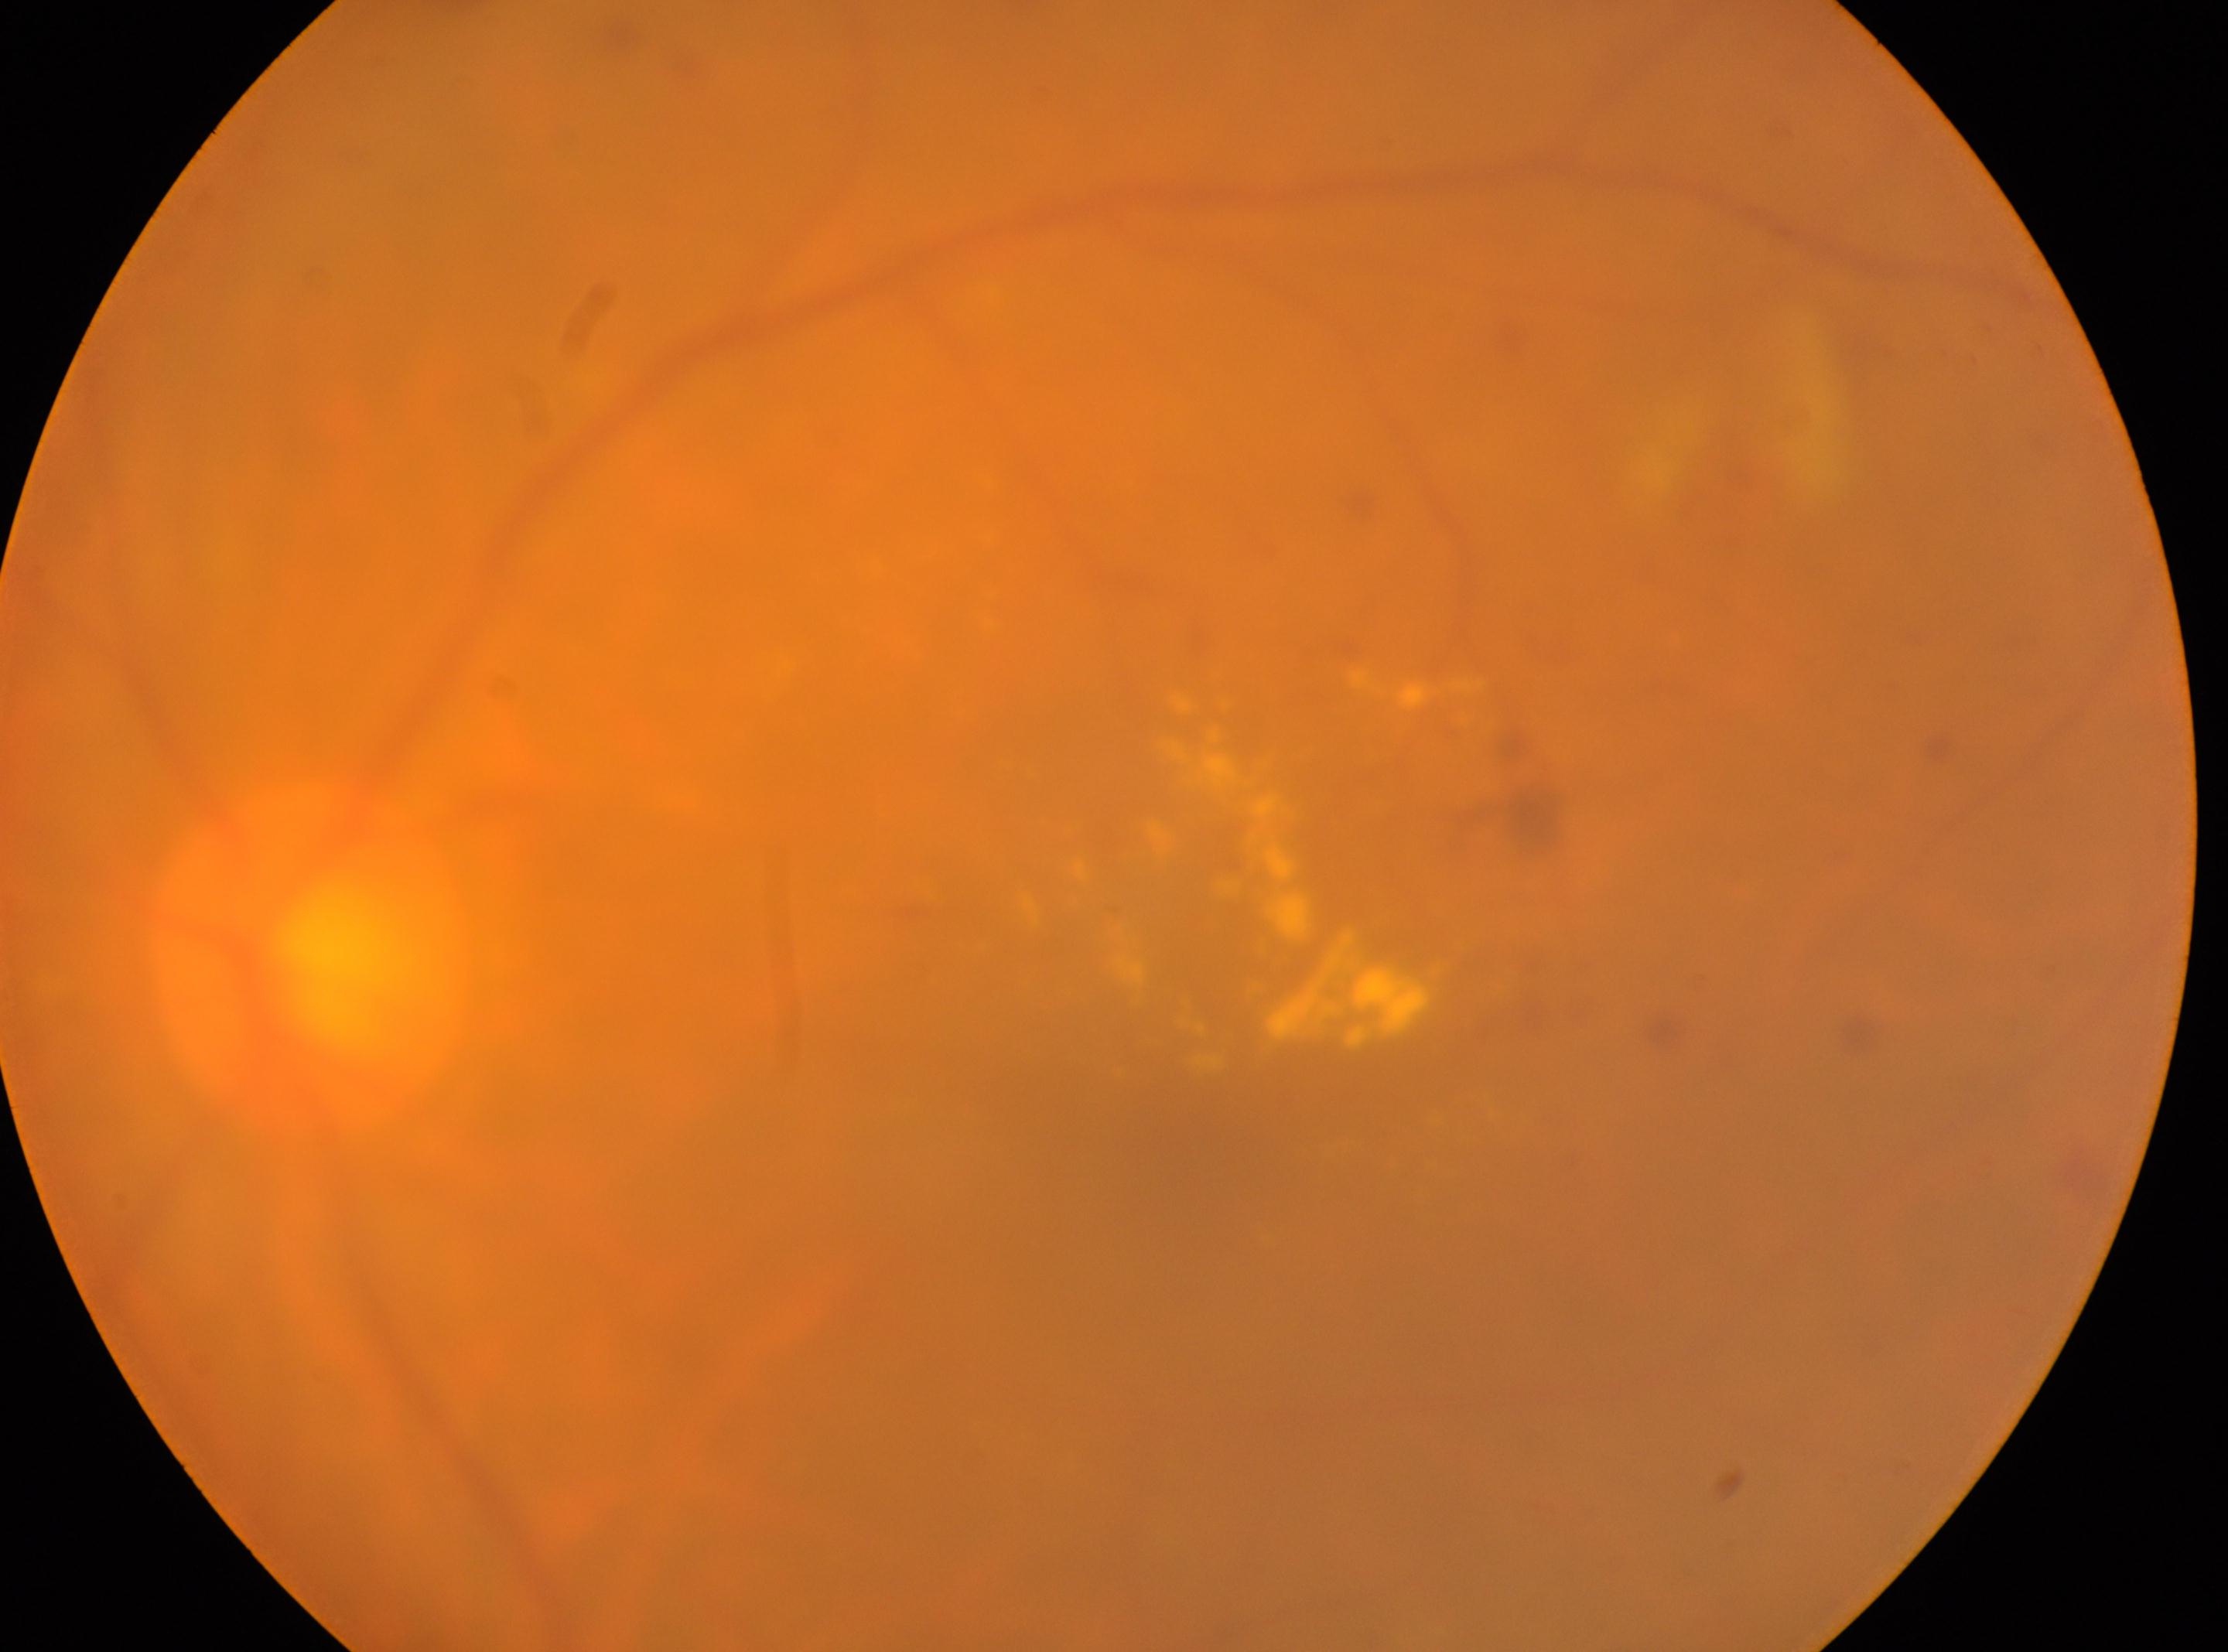

DR class: non-proliferative diabetic retinopathy.
Imaged eye: the left eye.
Foveal center: 1199px, 1152px.
Retinopathy: moderate non-proliferative diabetic retinopathy (grade 2).
The optic nerve head is at 309px, 964px.